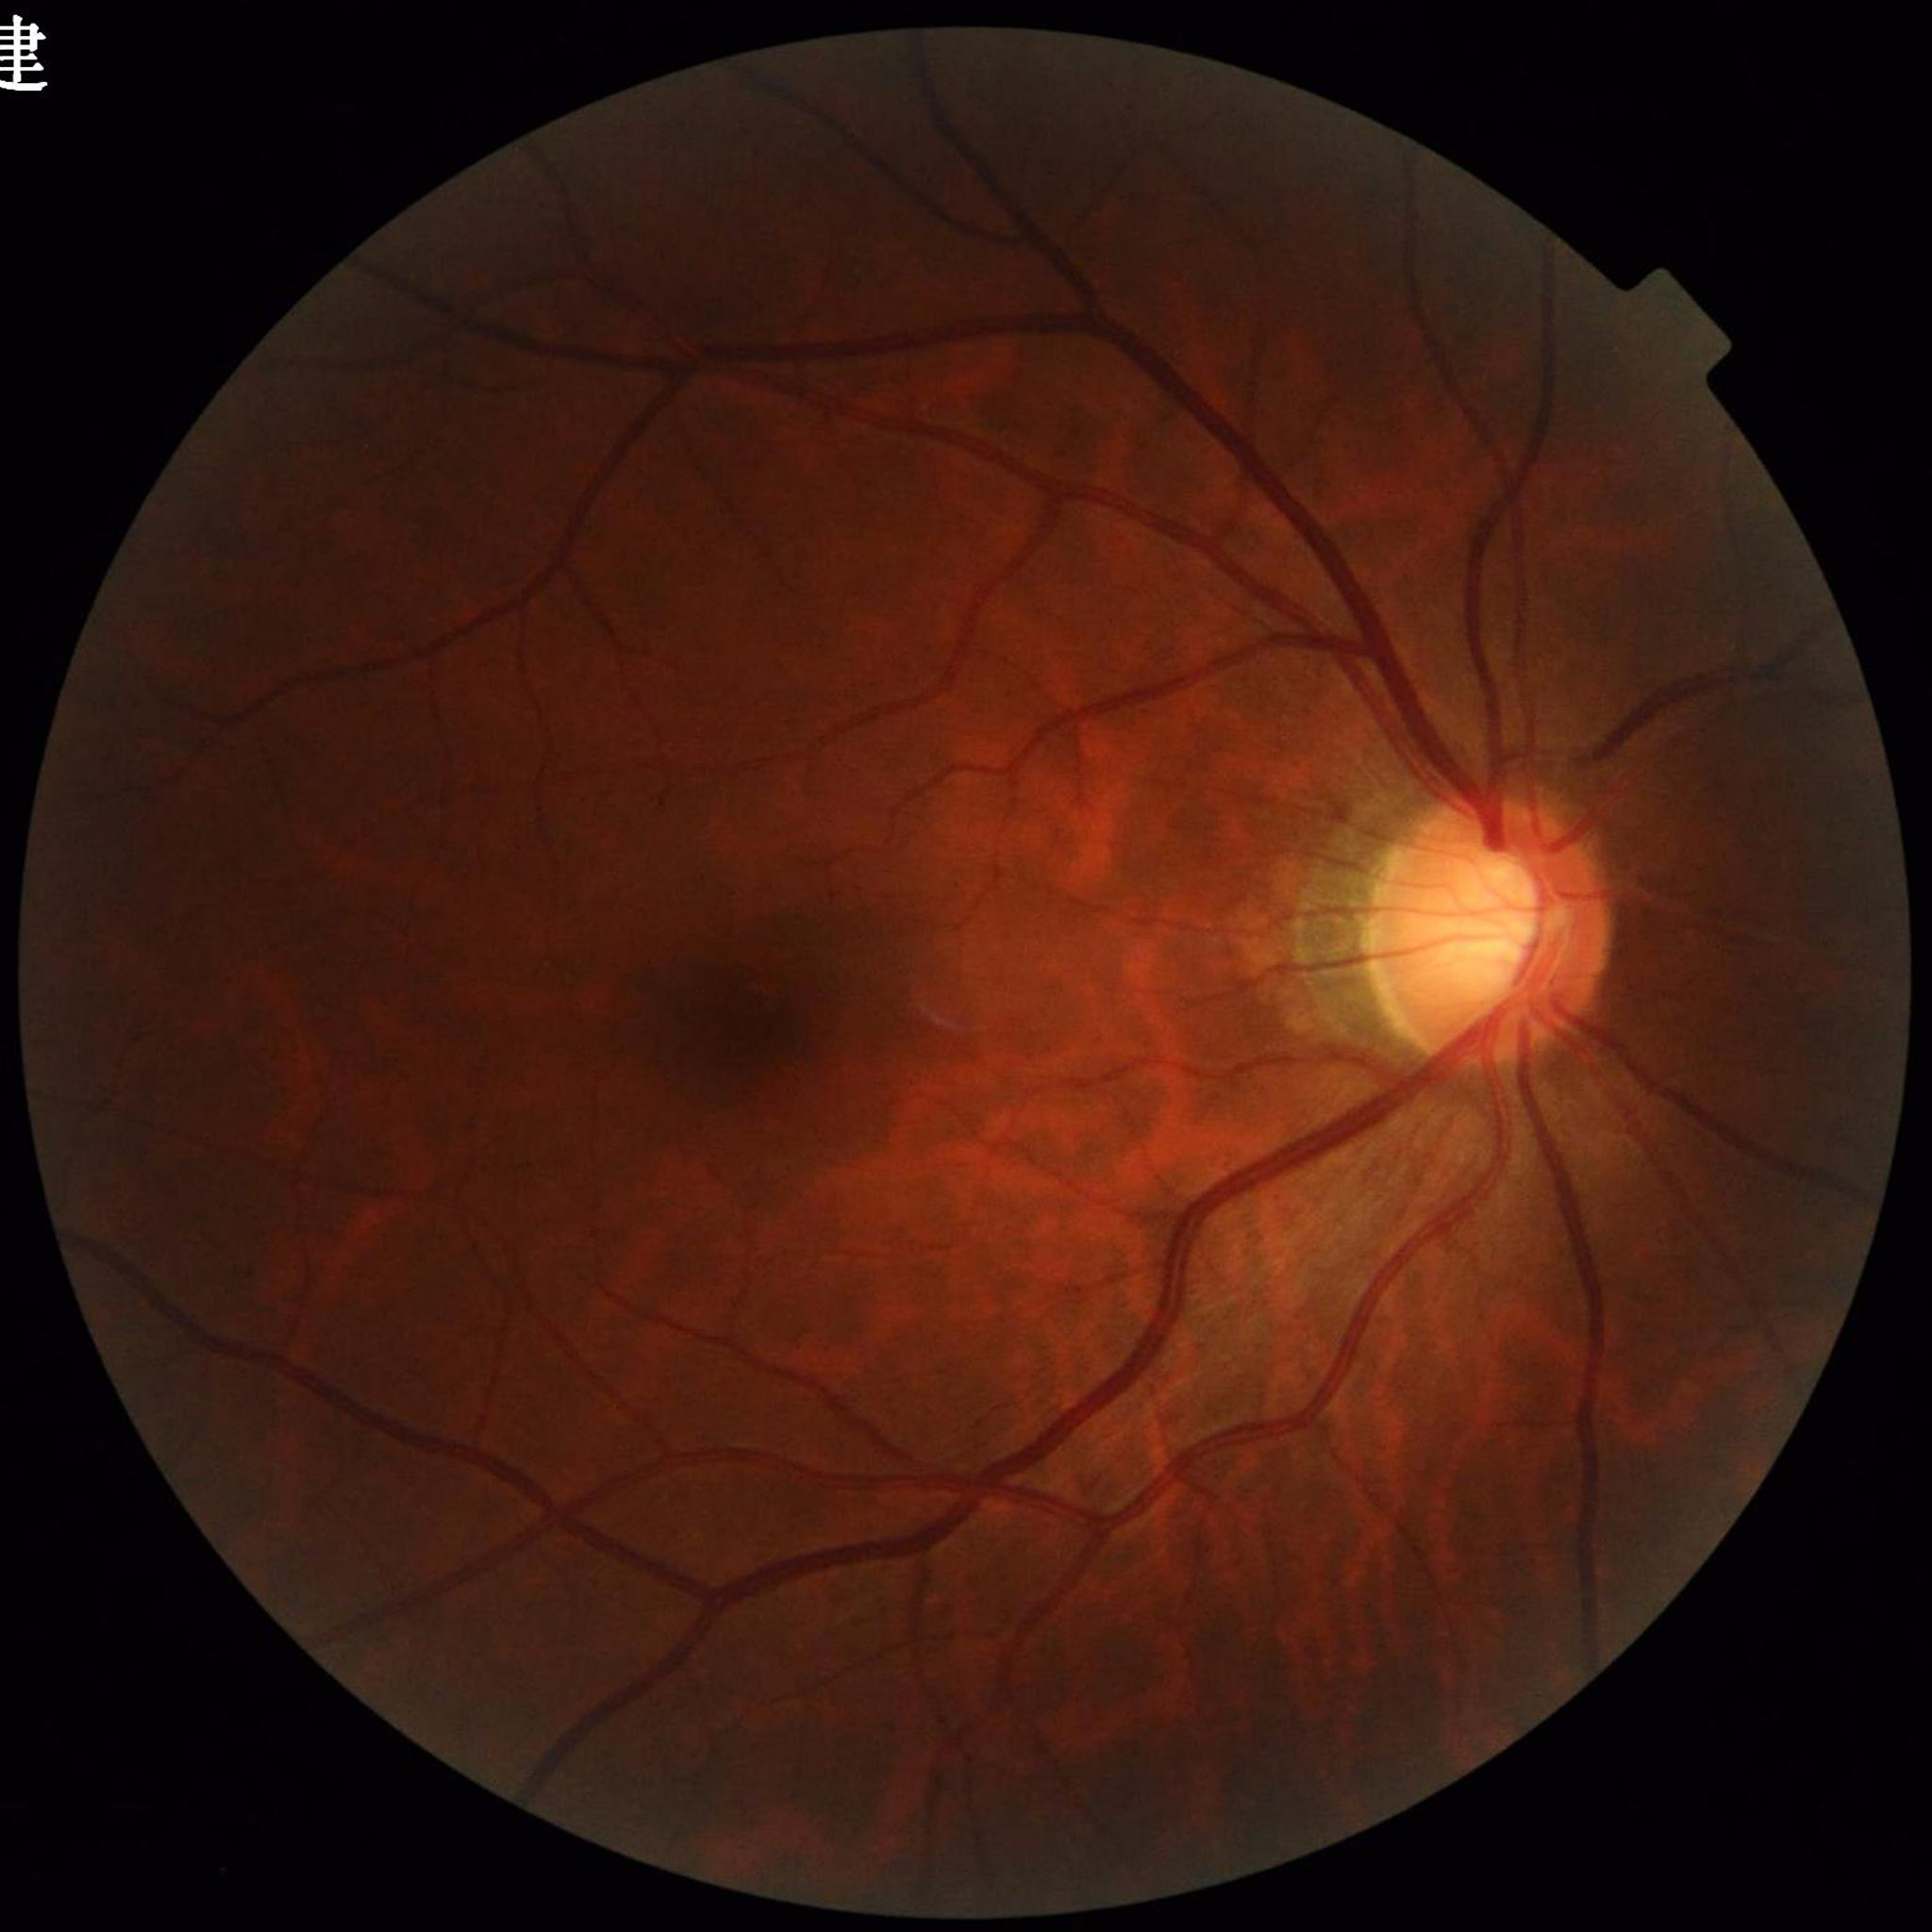

Diagnosed with glaucoma.